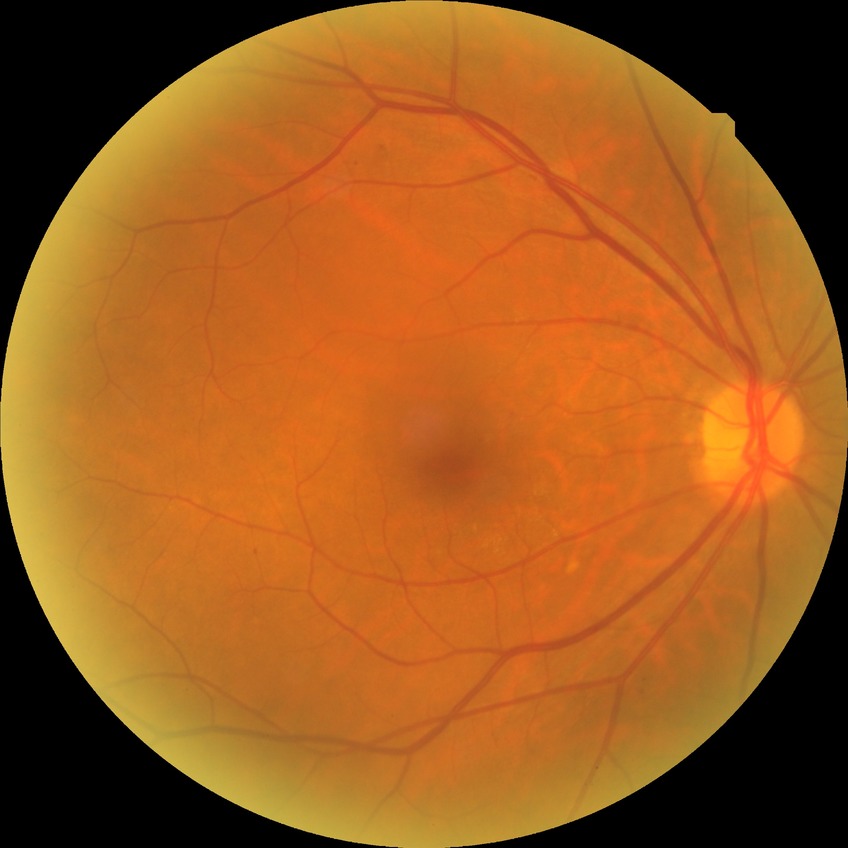
Diabetic retinopathy (DR) is simple diabetic retinopathy (SDR).